FOV: 45 degrees · fundus photo · 2212x1659:
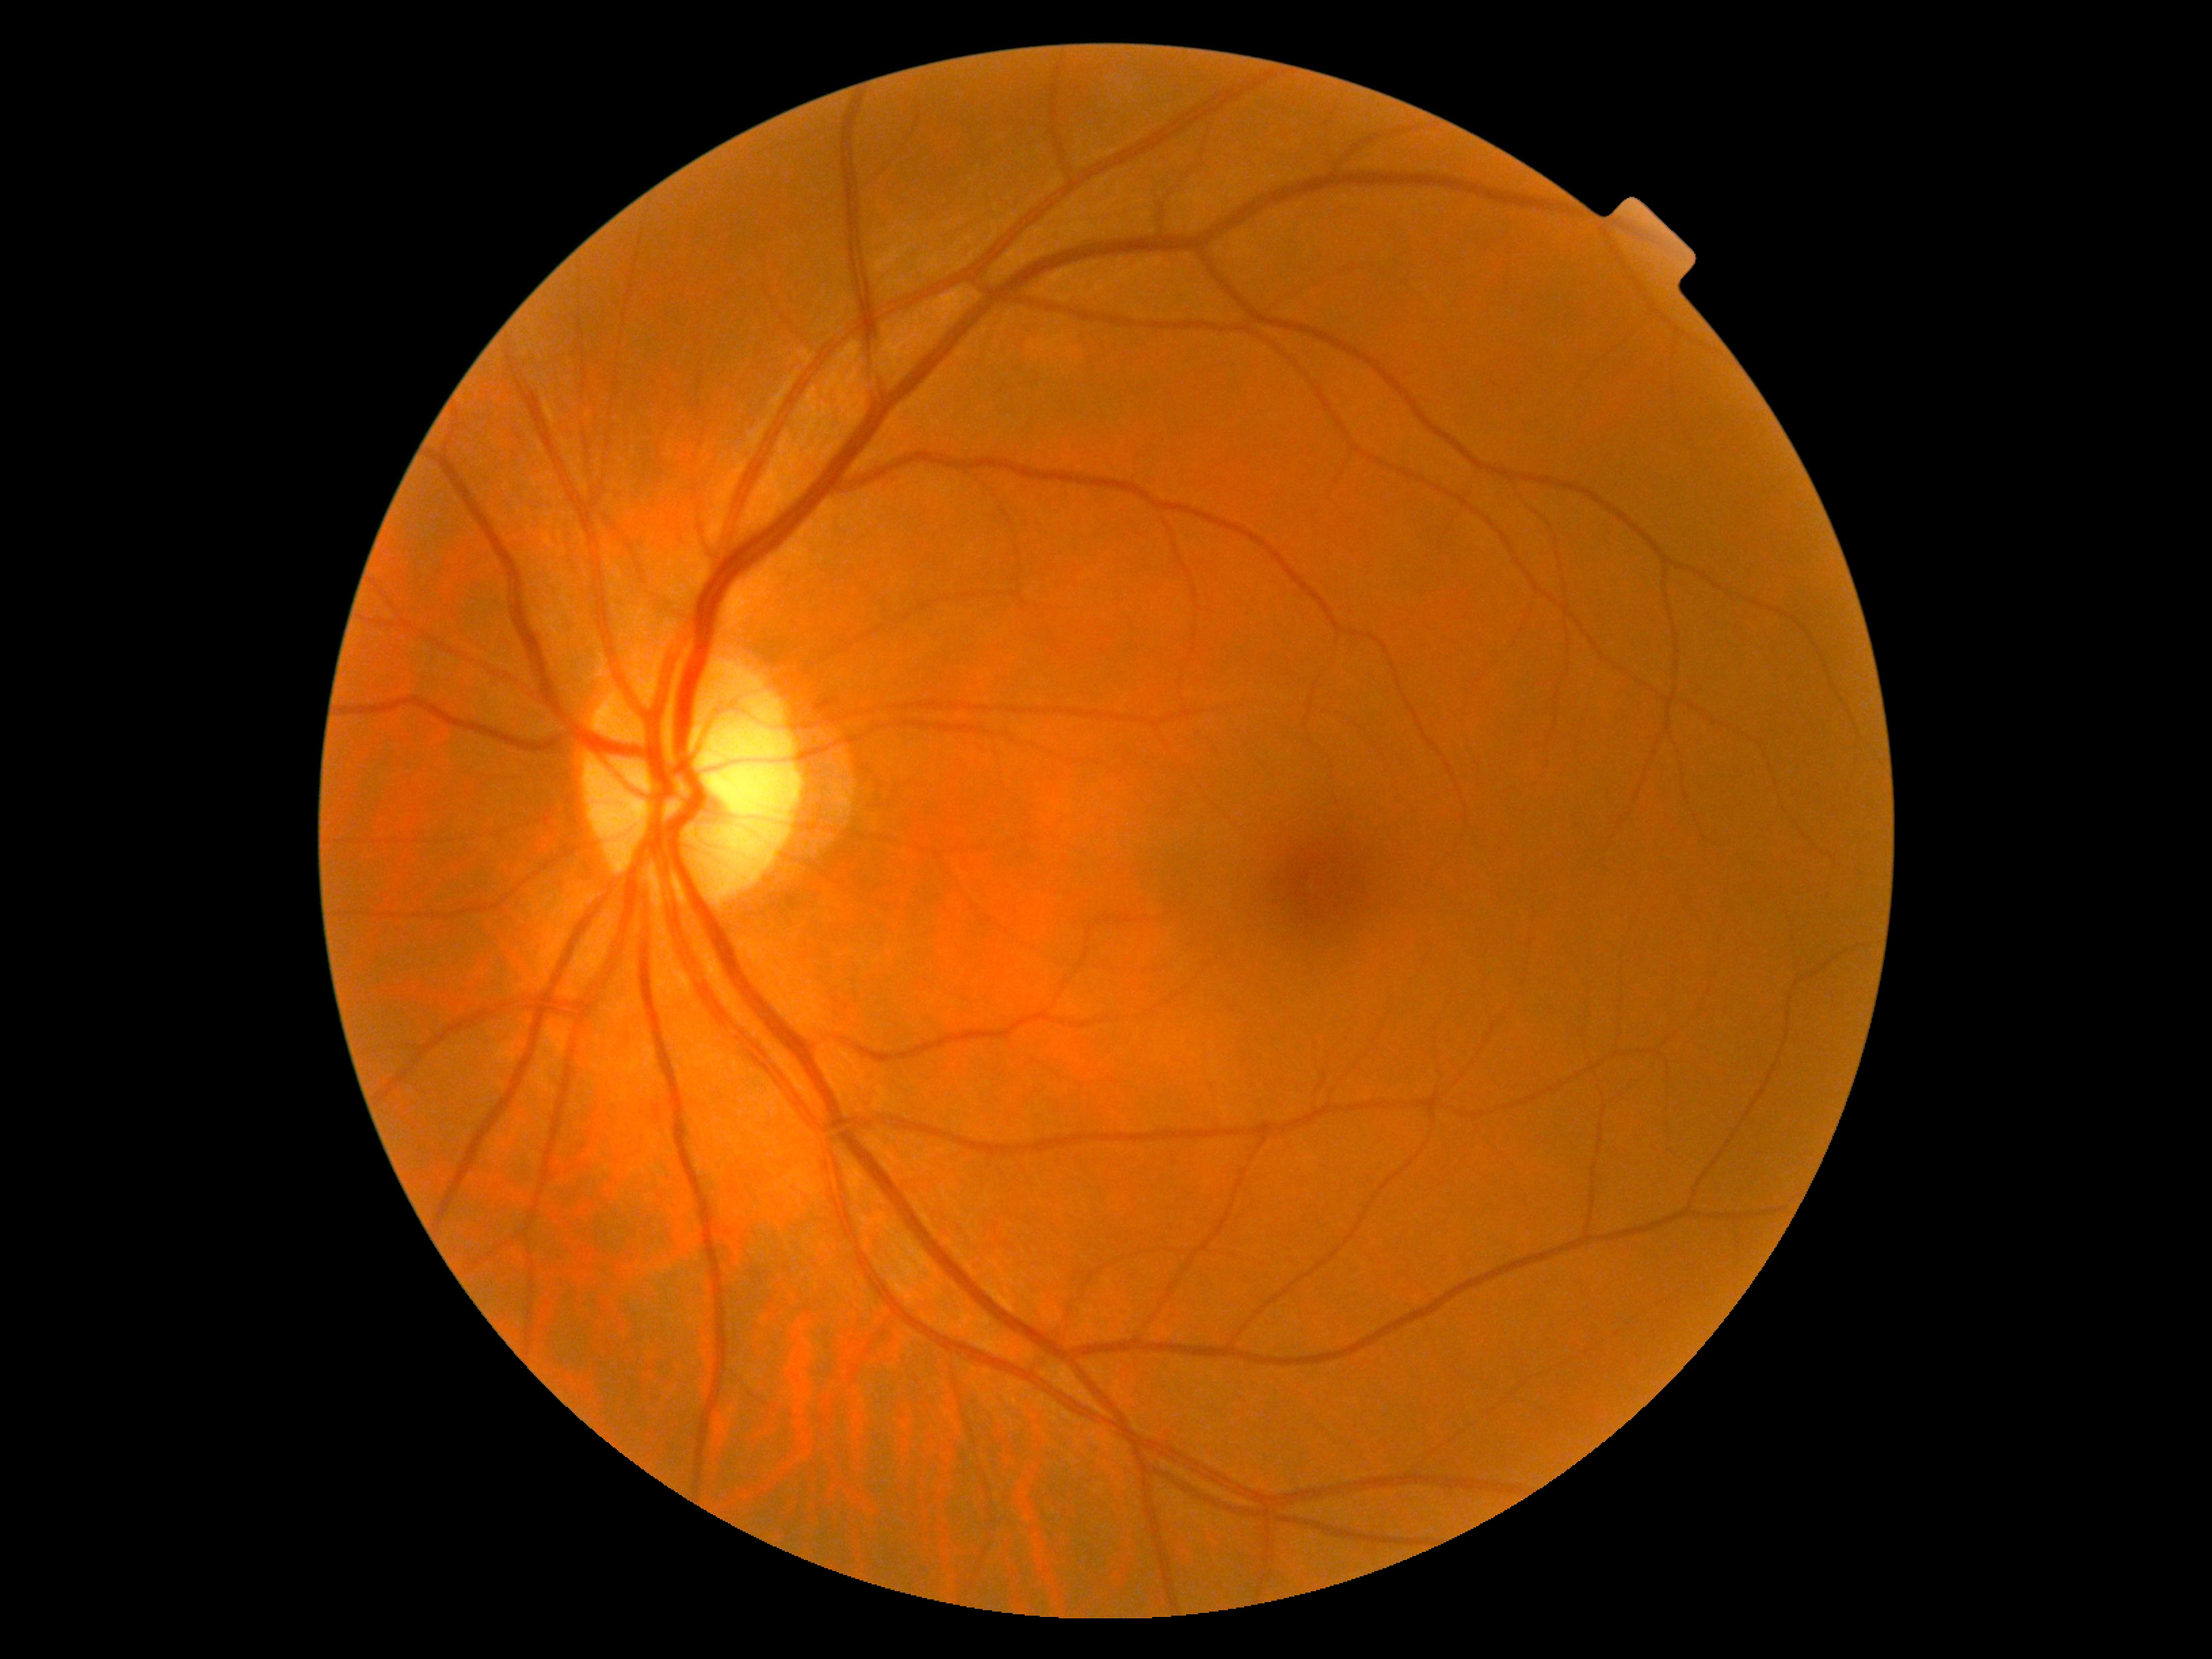

diabetic retinopathy (DR): 0/4